Infant wide-field fundus photograph.
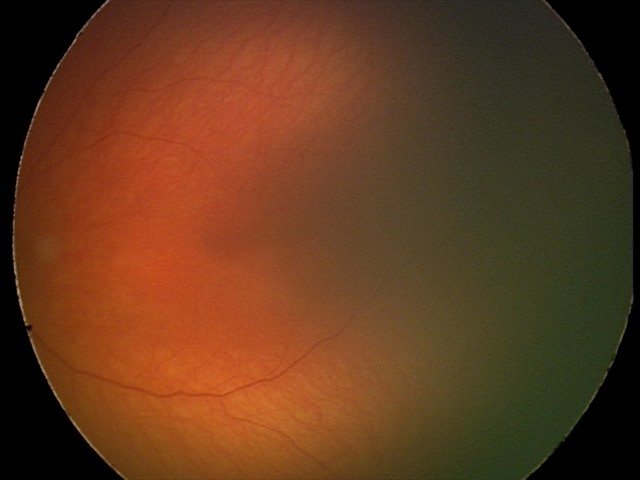

Normal screening examination.